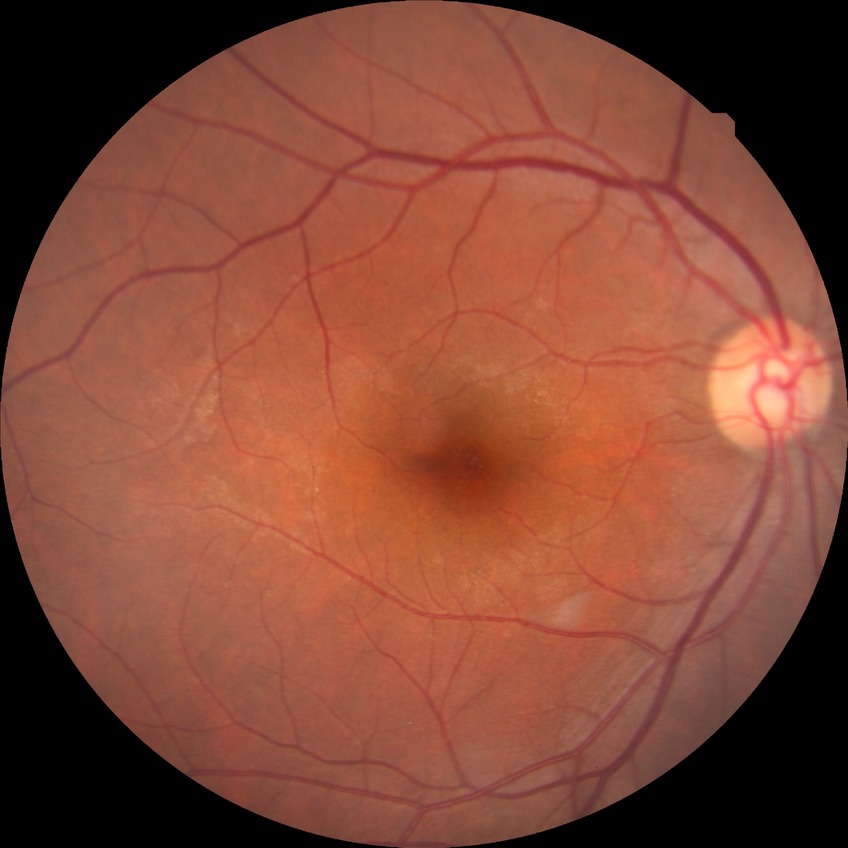 diabetic retinopathy severity: no diabetic retinopathy.